848 x 848 pixels.
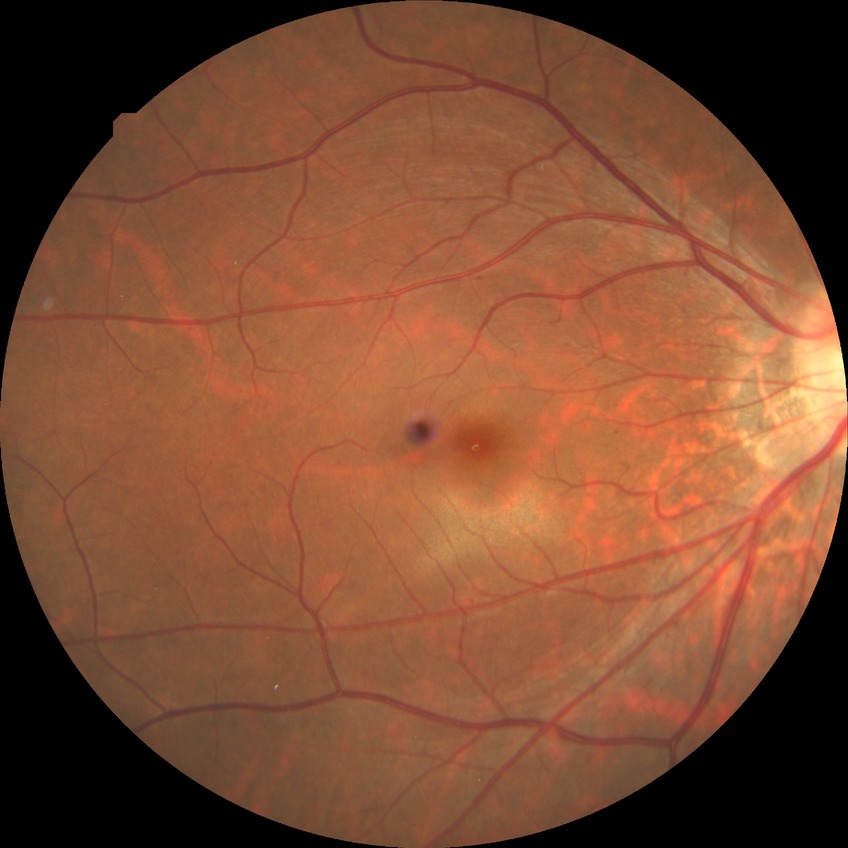
Modified Davis grade: SDR.